Without pupil dilation; Davis DR grading — 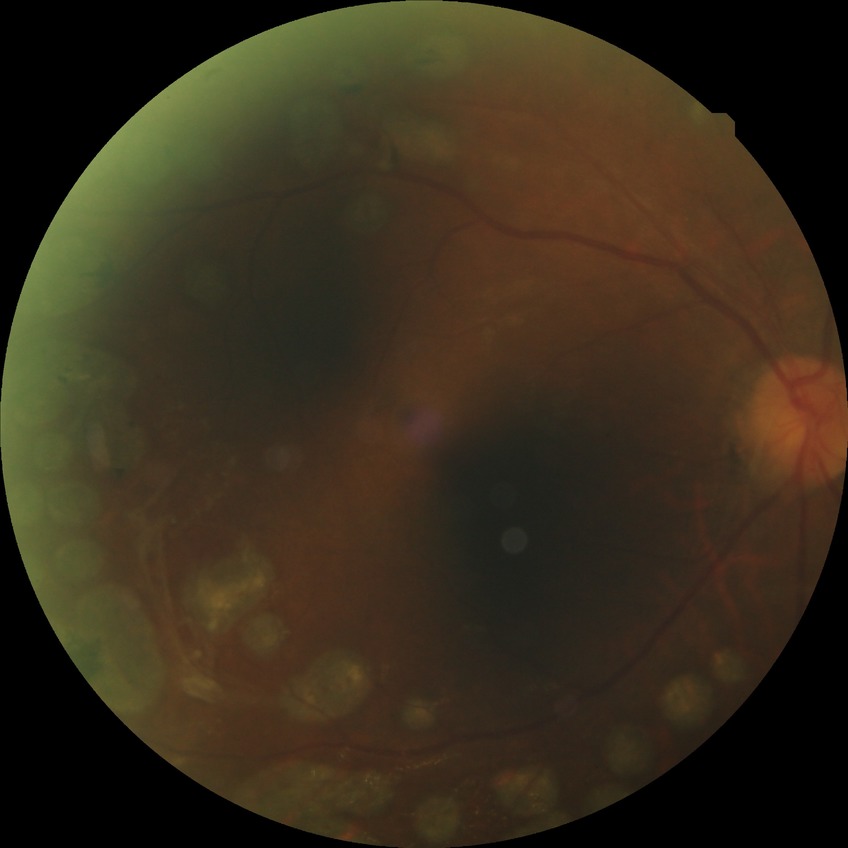
Assessment:
• retinopathy stage — proliferative diabetic retinopathy